Posterior pole view · Topcon TRC-50DX · 50° field of view: 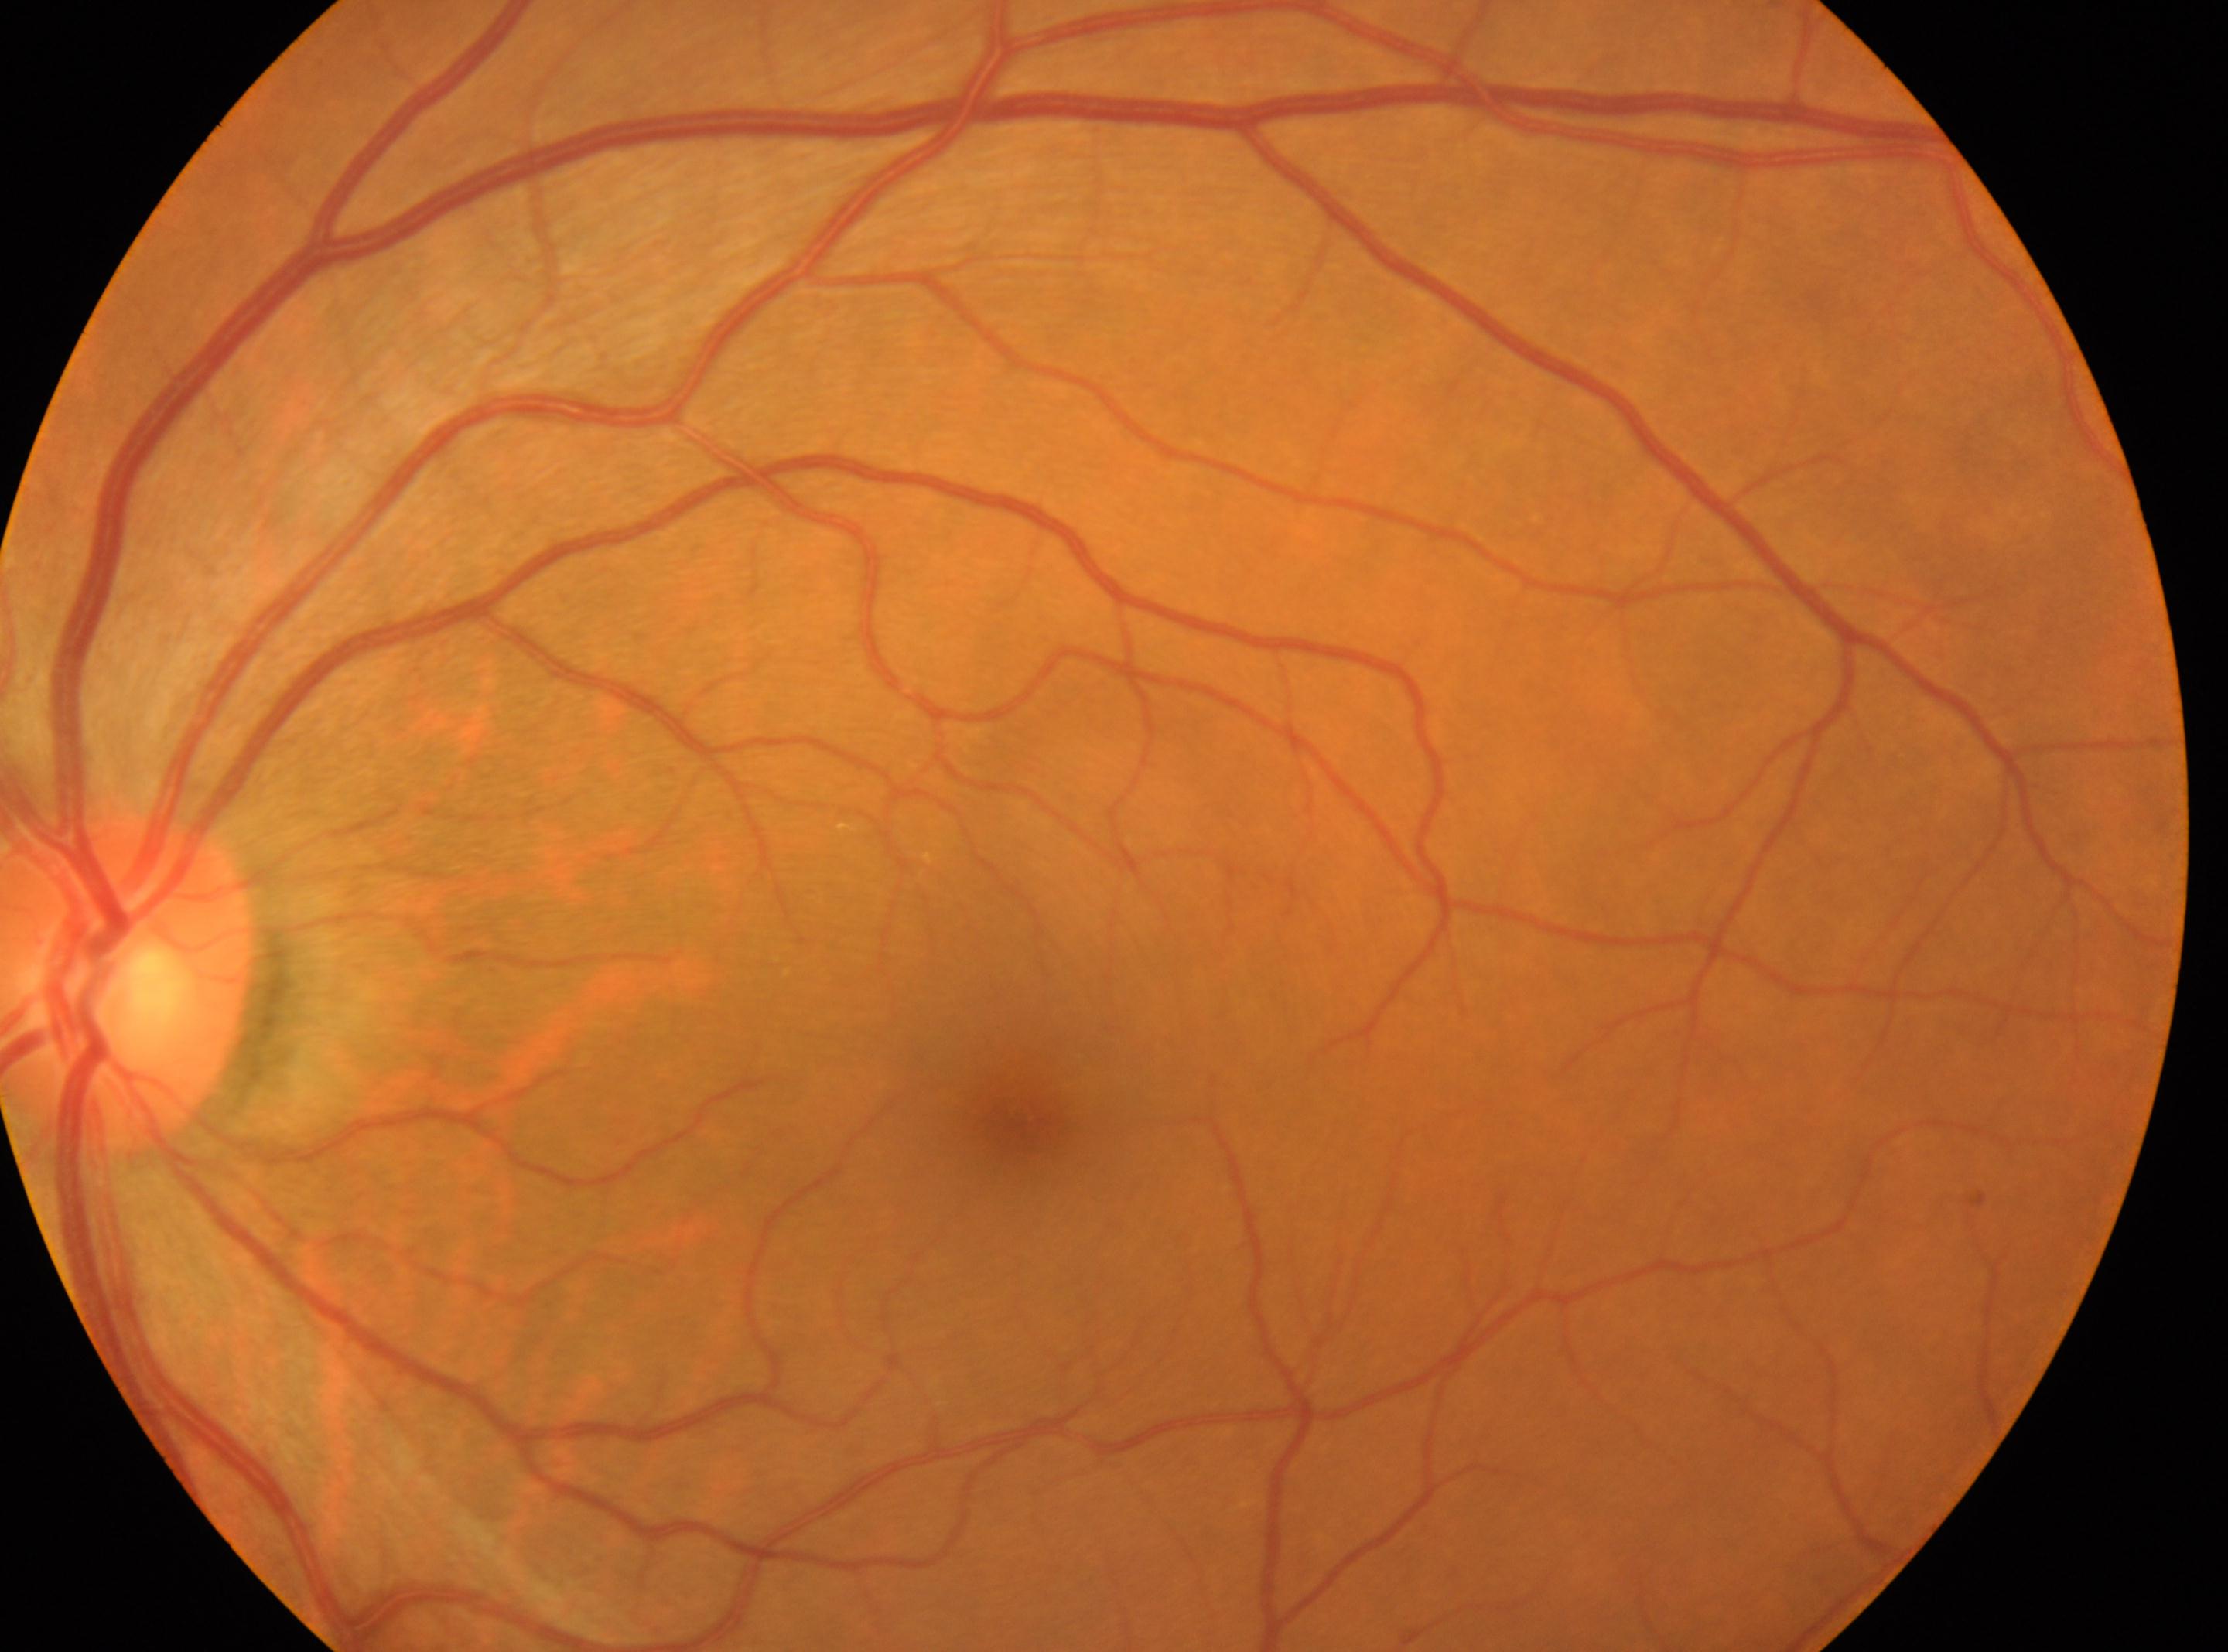 fovea center = (1021,1128) | optic disk = (128,983) | diabetic retinopathy (DR) = 0/4 — no visible signs of diabetic retinopathy | laterality = oculus sinister.